FOV: 45 degrees: 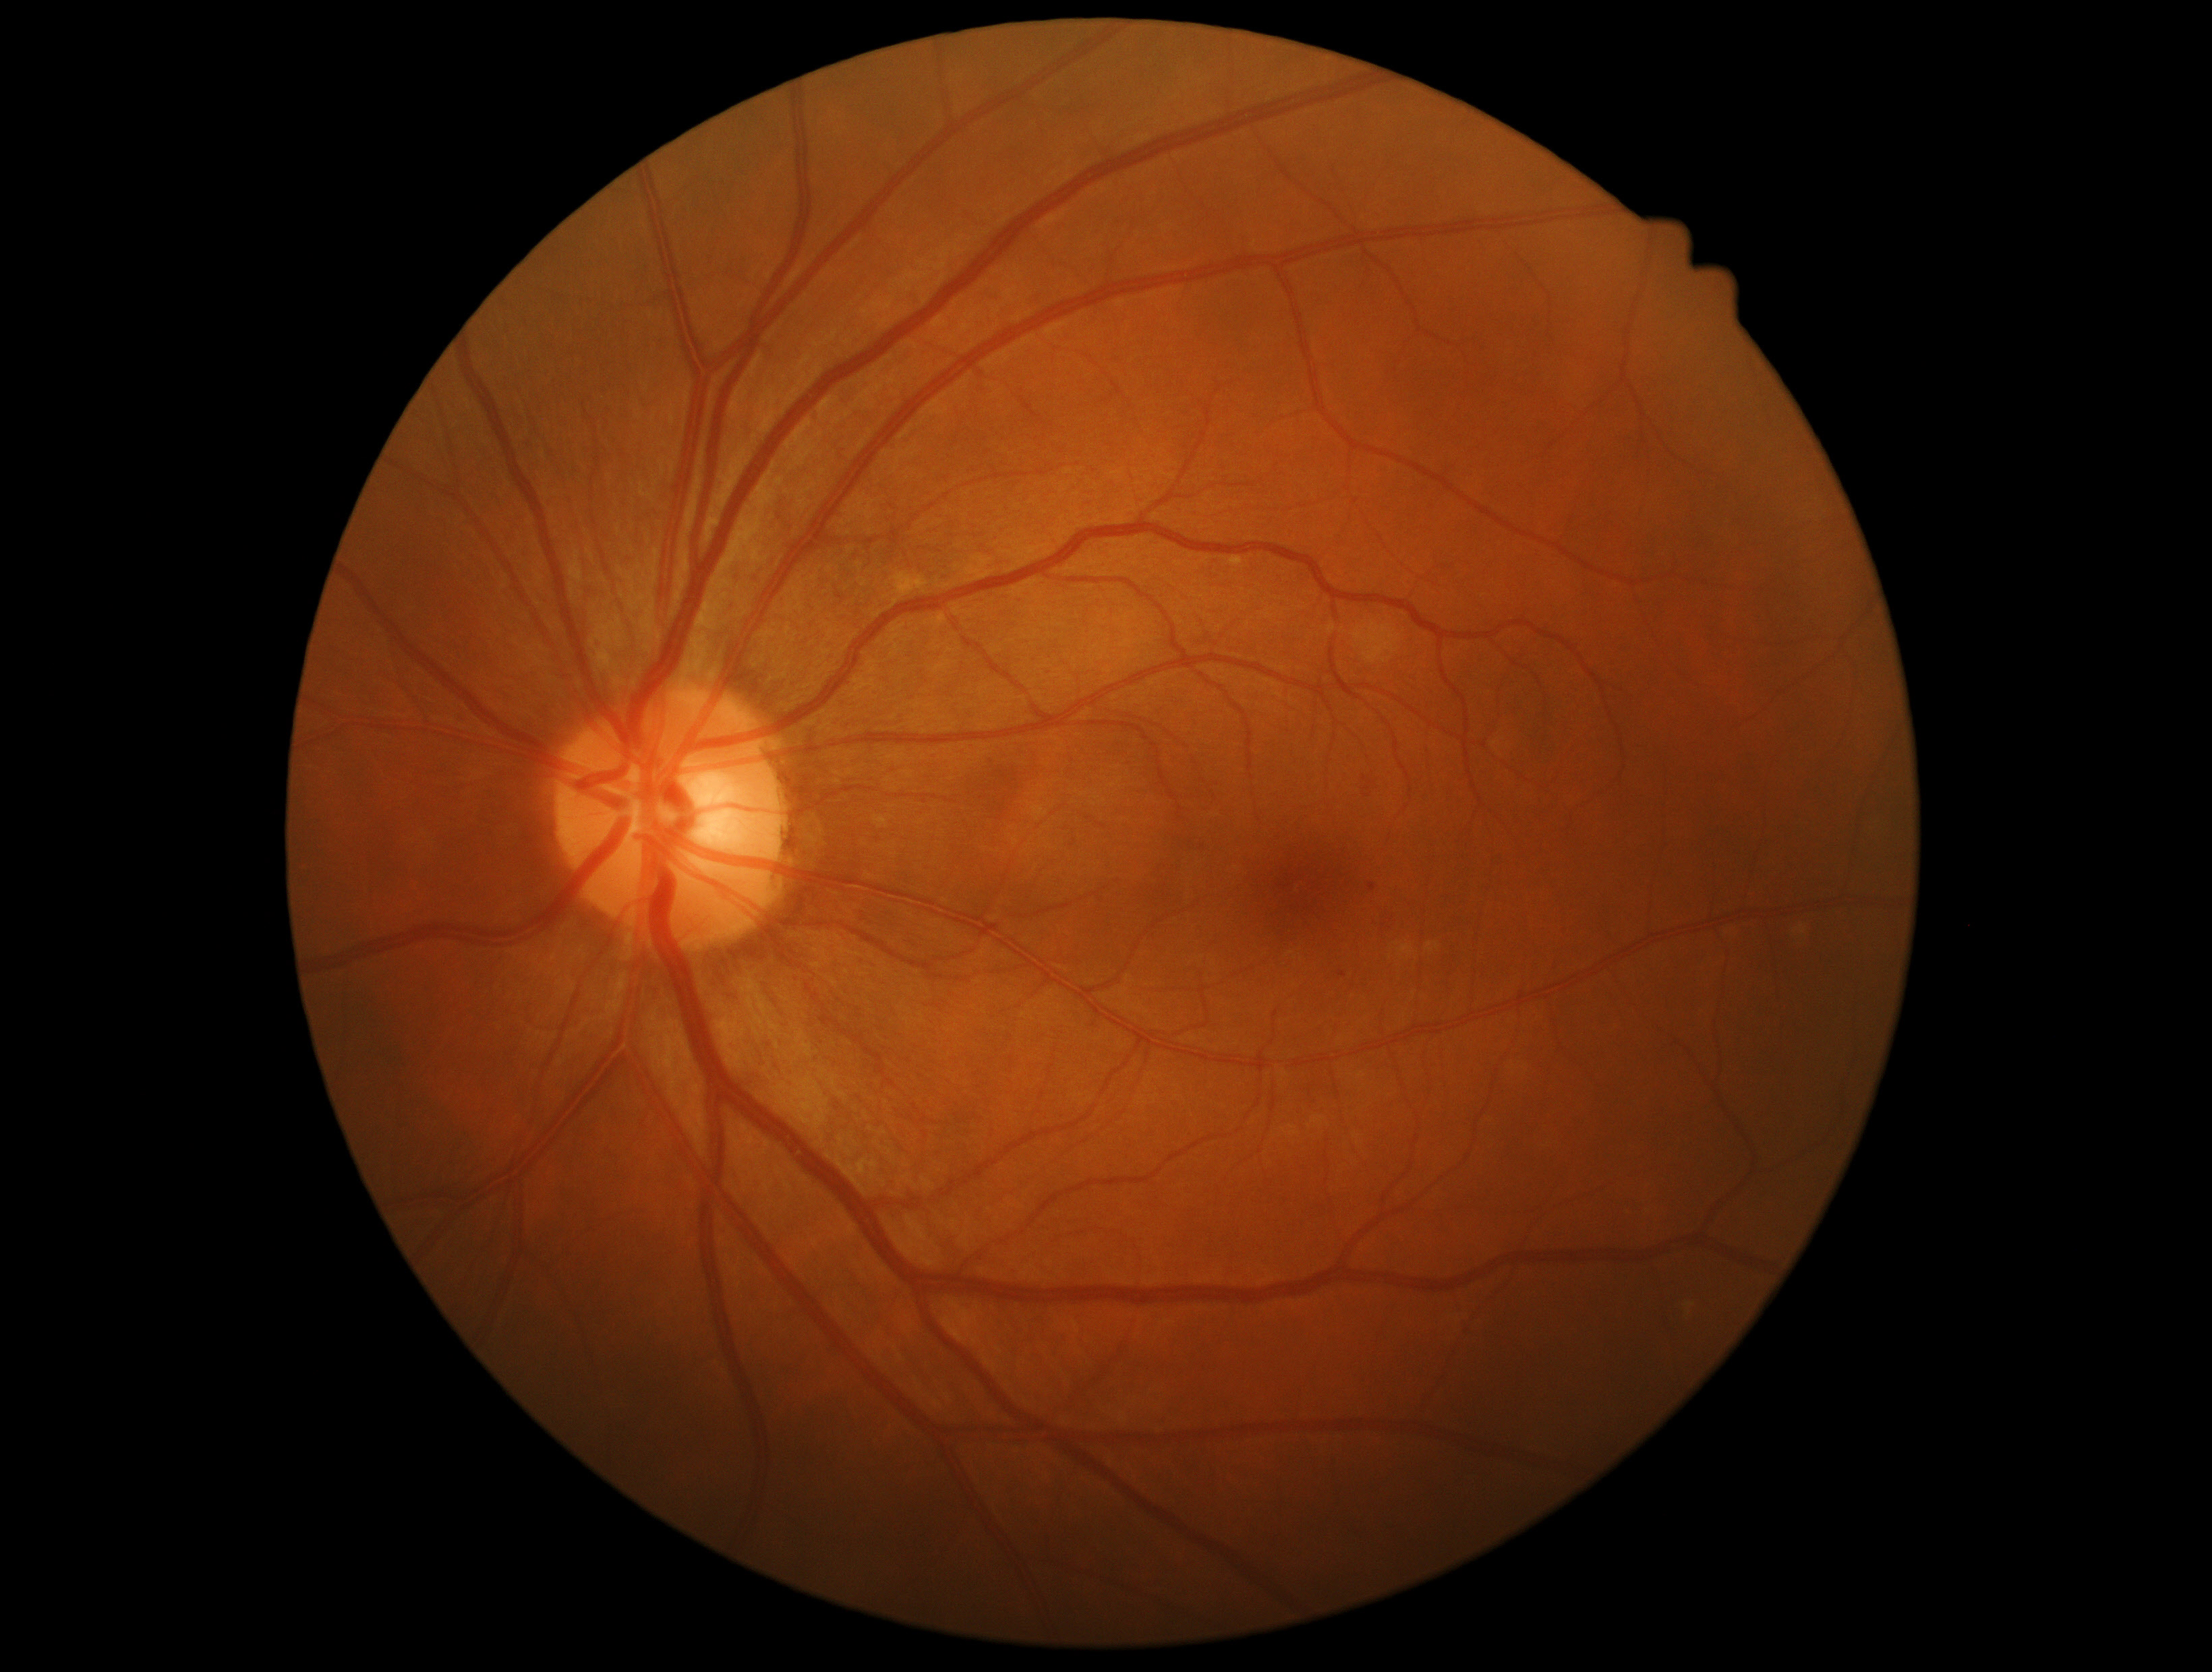

DR grade: mild NPDR (1).
The retinopathy is classified as non-proliferative diabetic retinopathy.